Pediatric wide-field fundus photograph · camera: Clarity RetCam 3 (130° FOV)
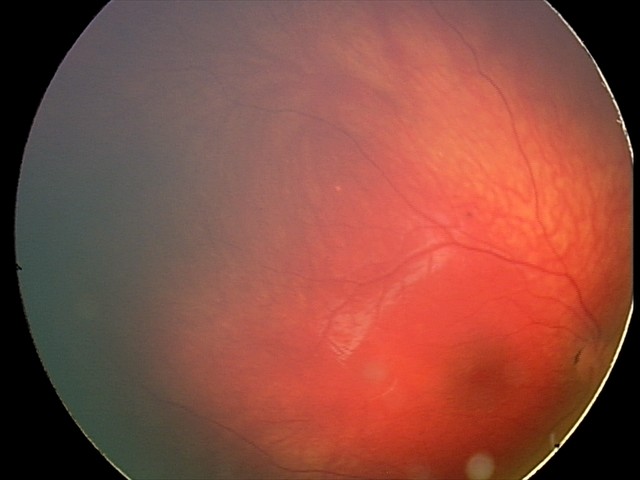
From an examination with diagnosis of retinal astrocytic hamartoma.